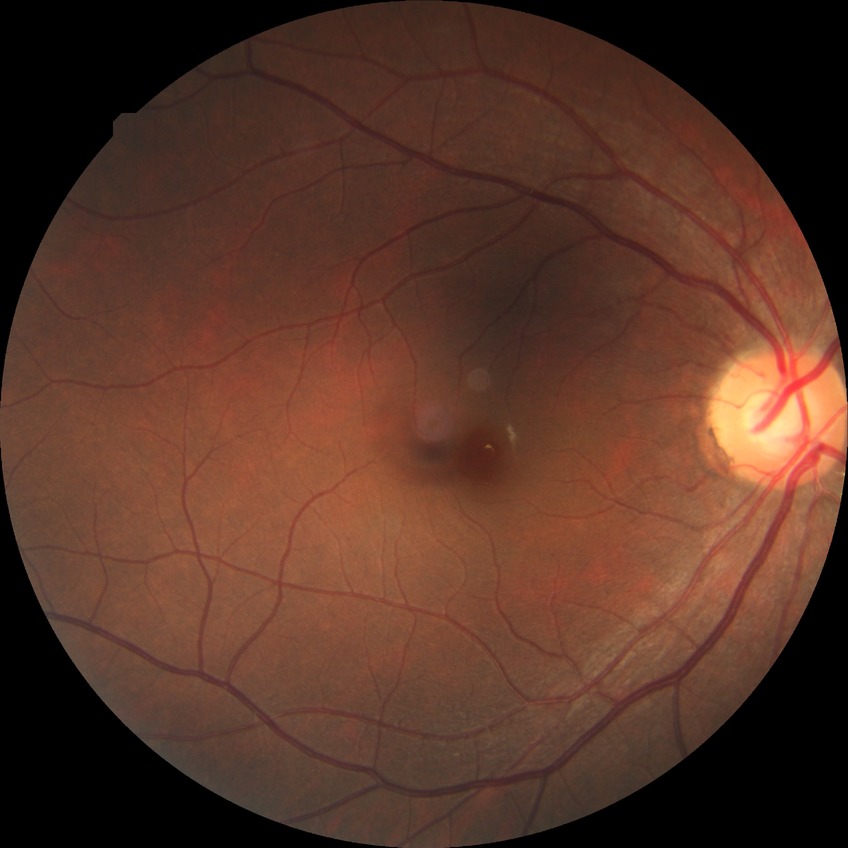

Diabetic retinopathy (DR): no diabetic retinopathy (NDR).